DR severity per modified Davis staging — 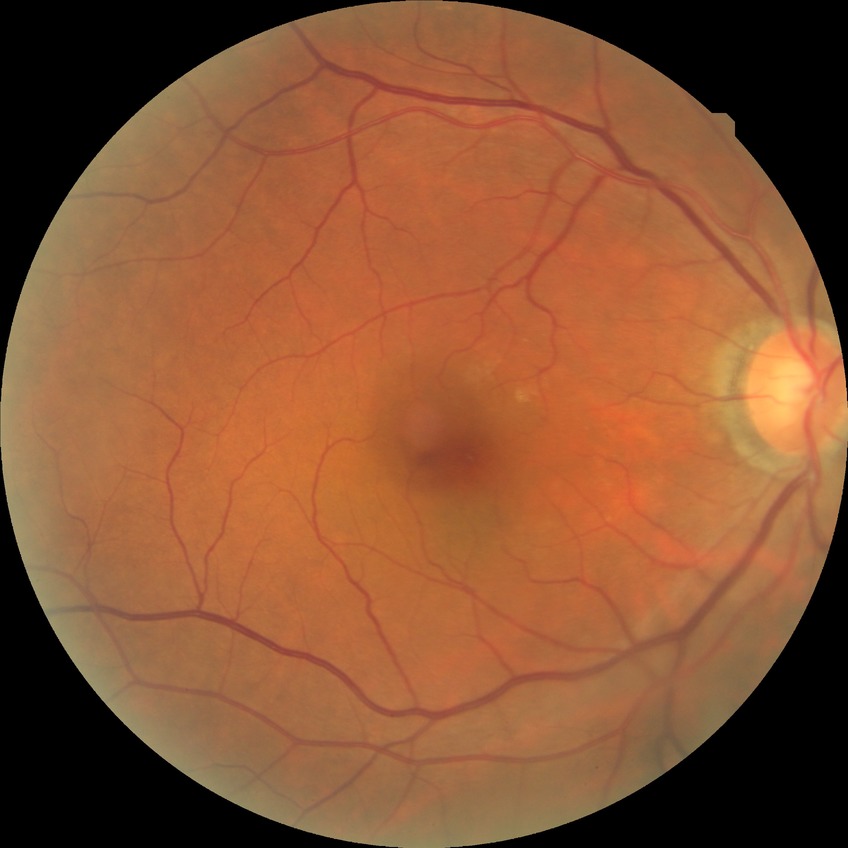 diabetic retinopathy (DR)=no diabetic retinopathy (NDR).